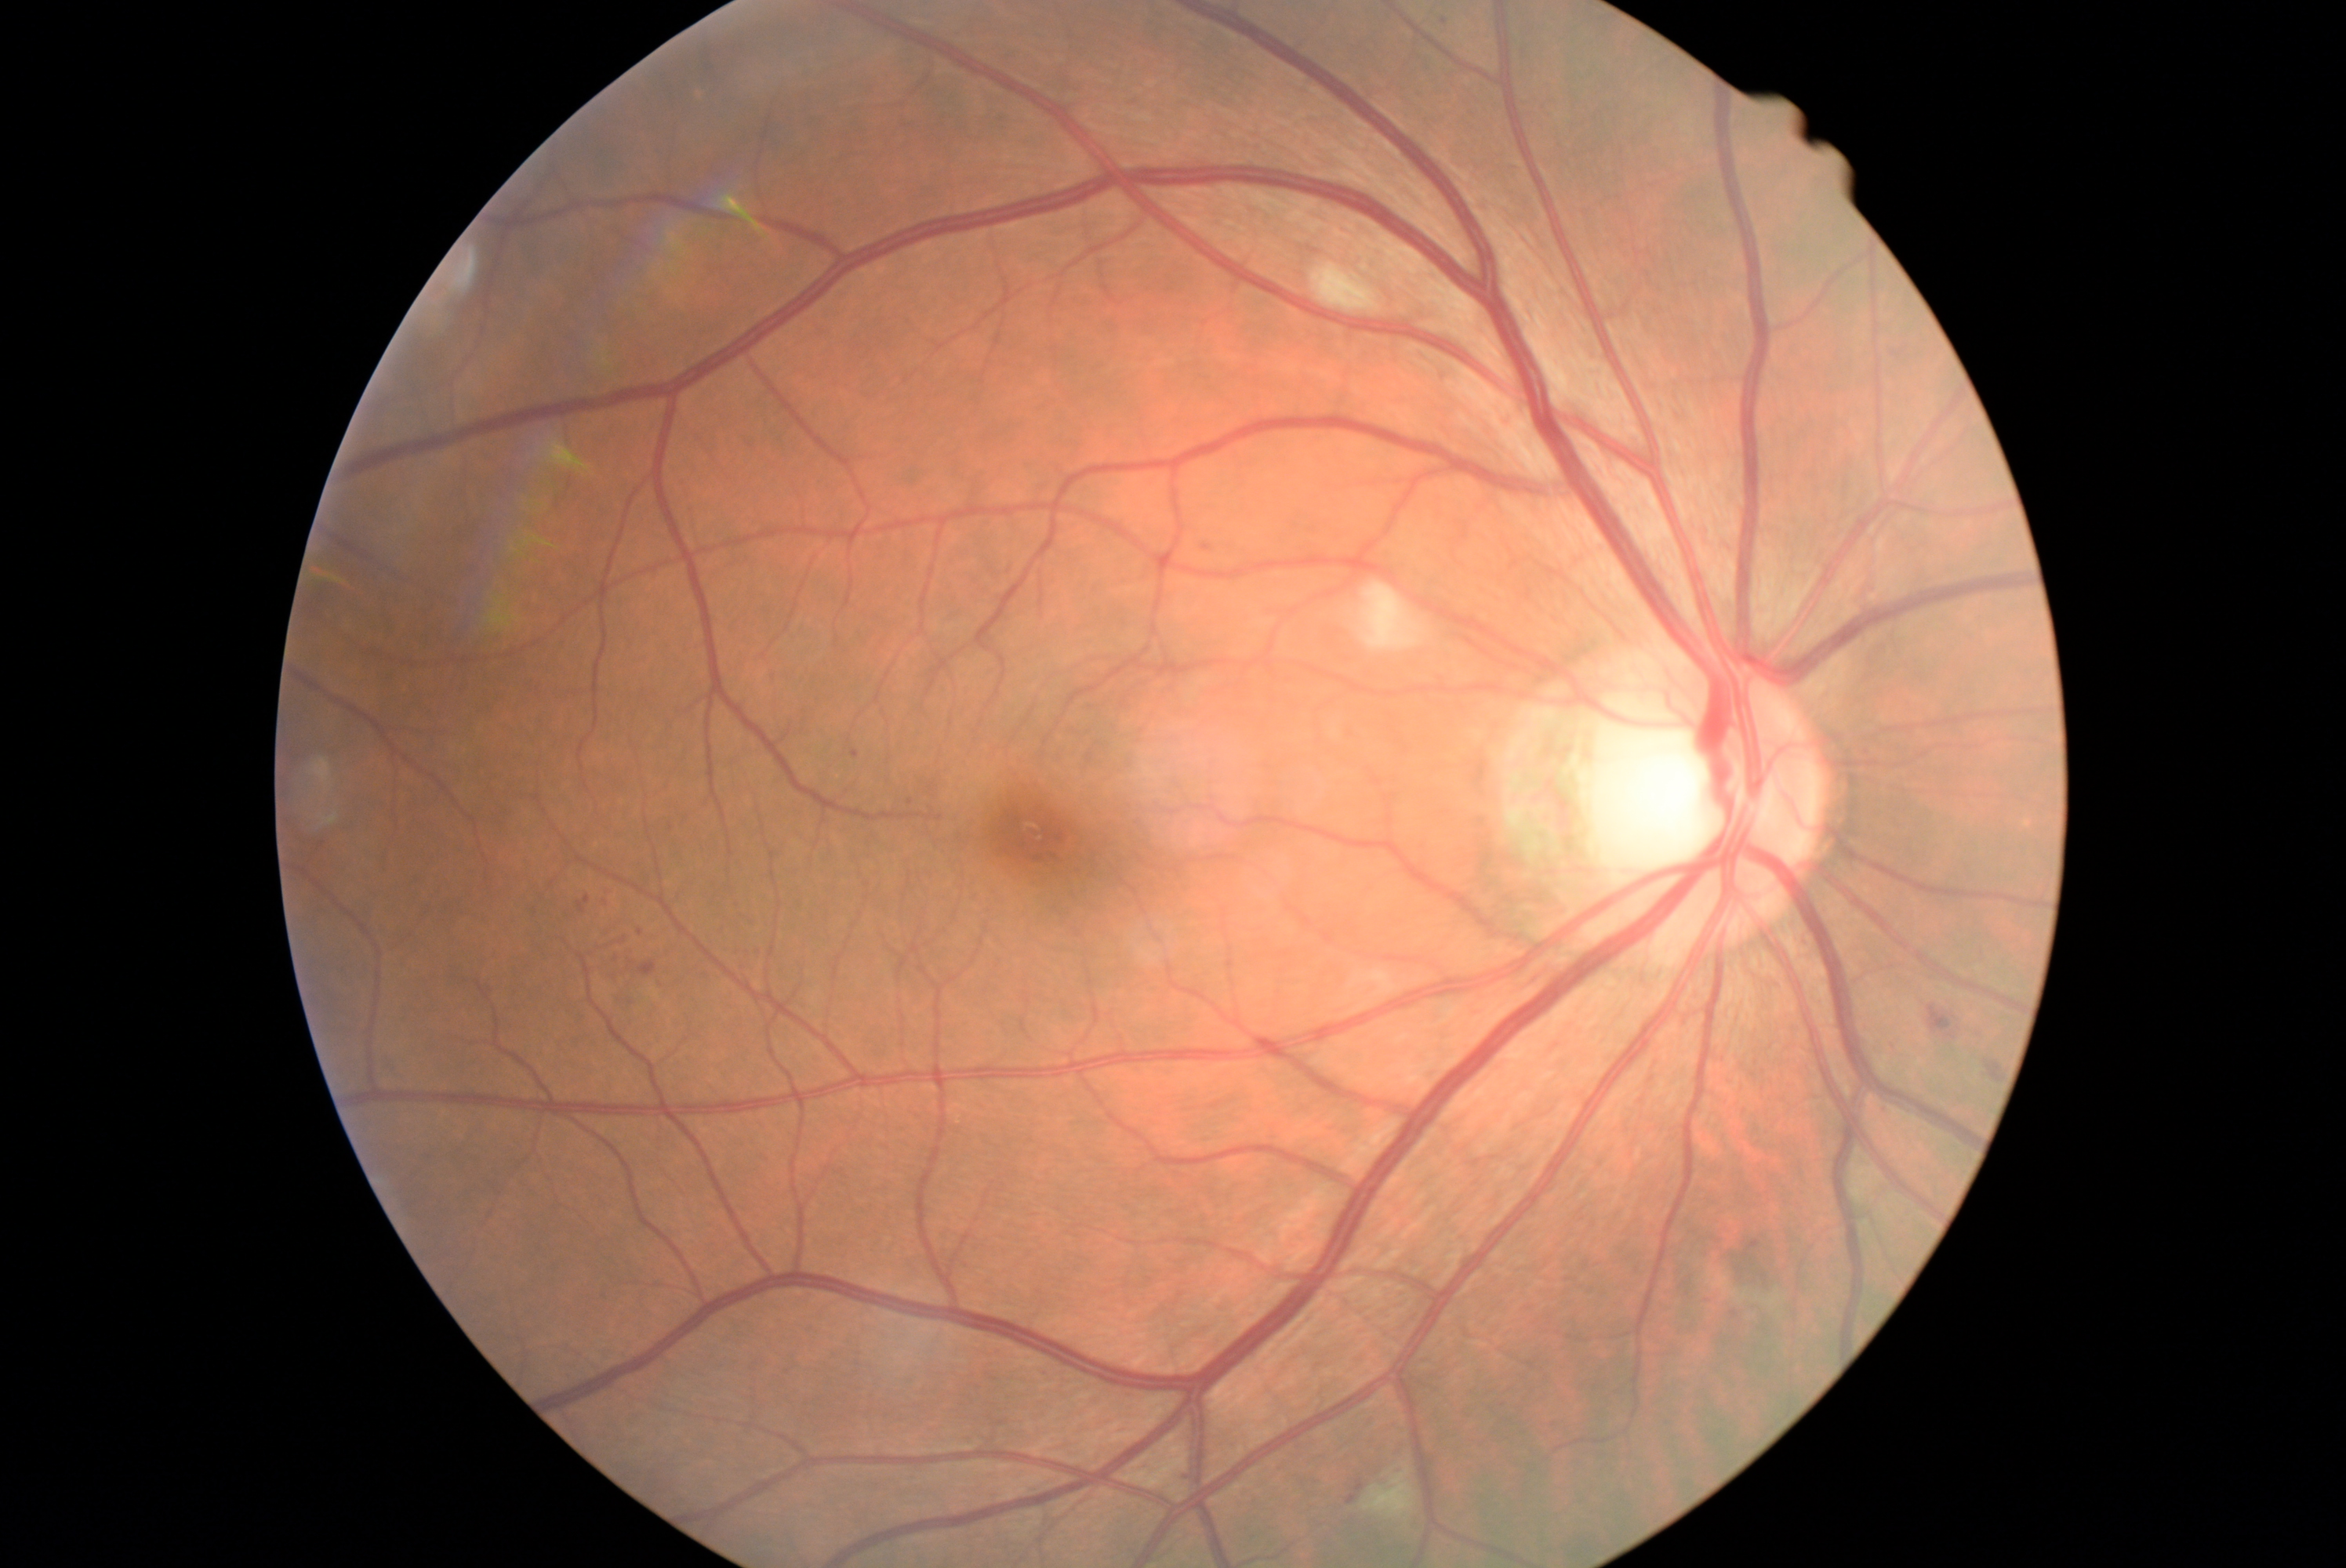 retinopathy grade = 2 (moderate NPDR) — more than just microaneurysms but less than severe NPDR